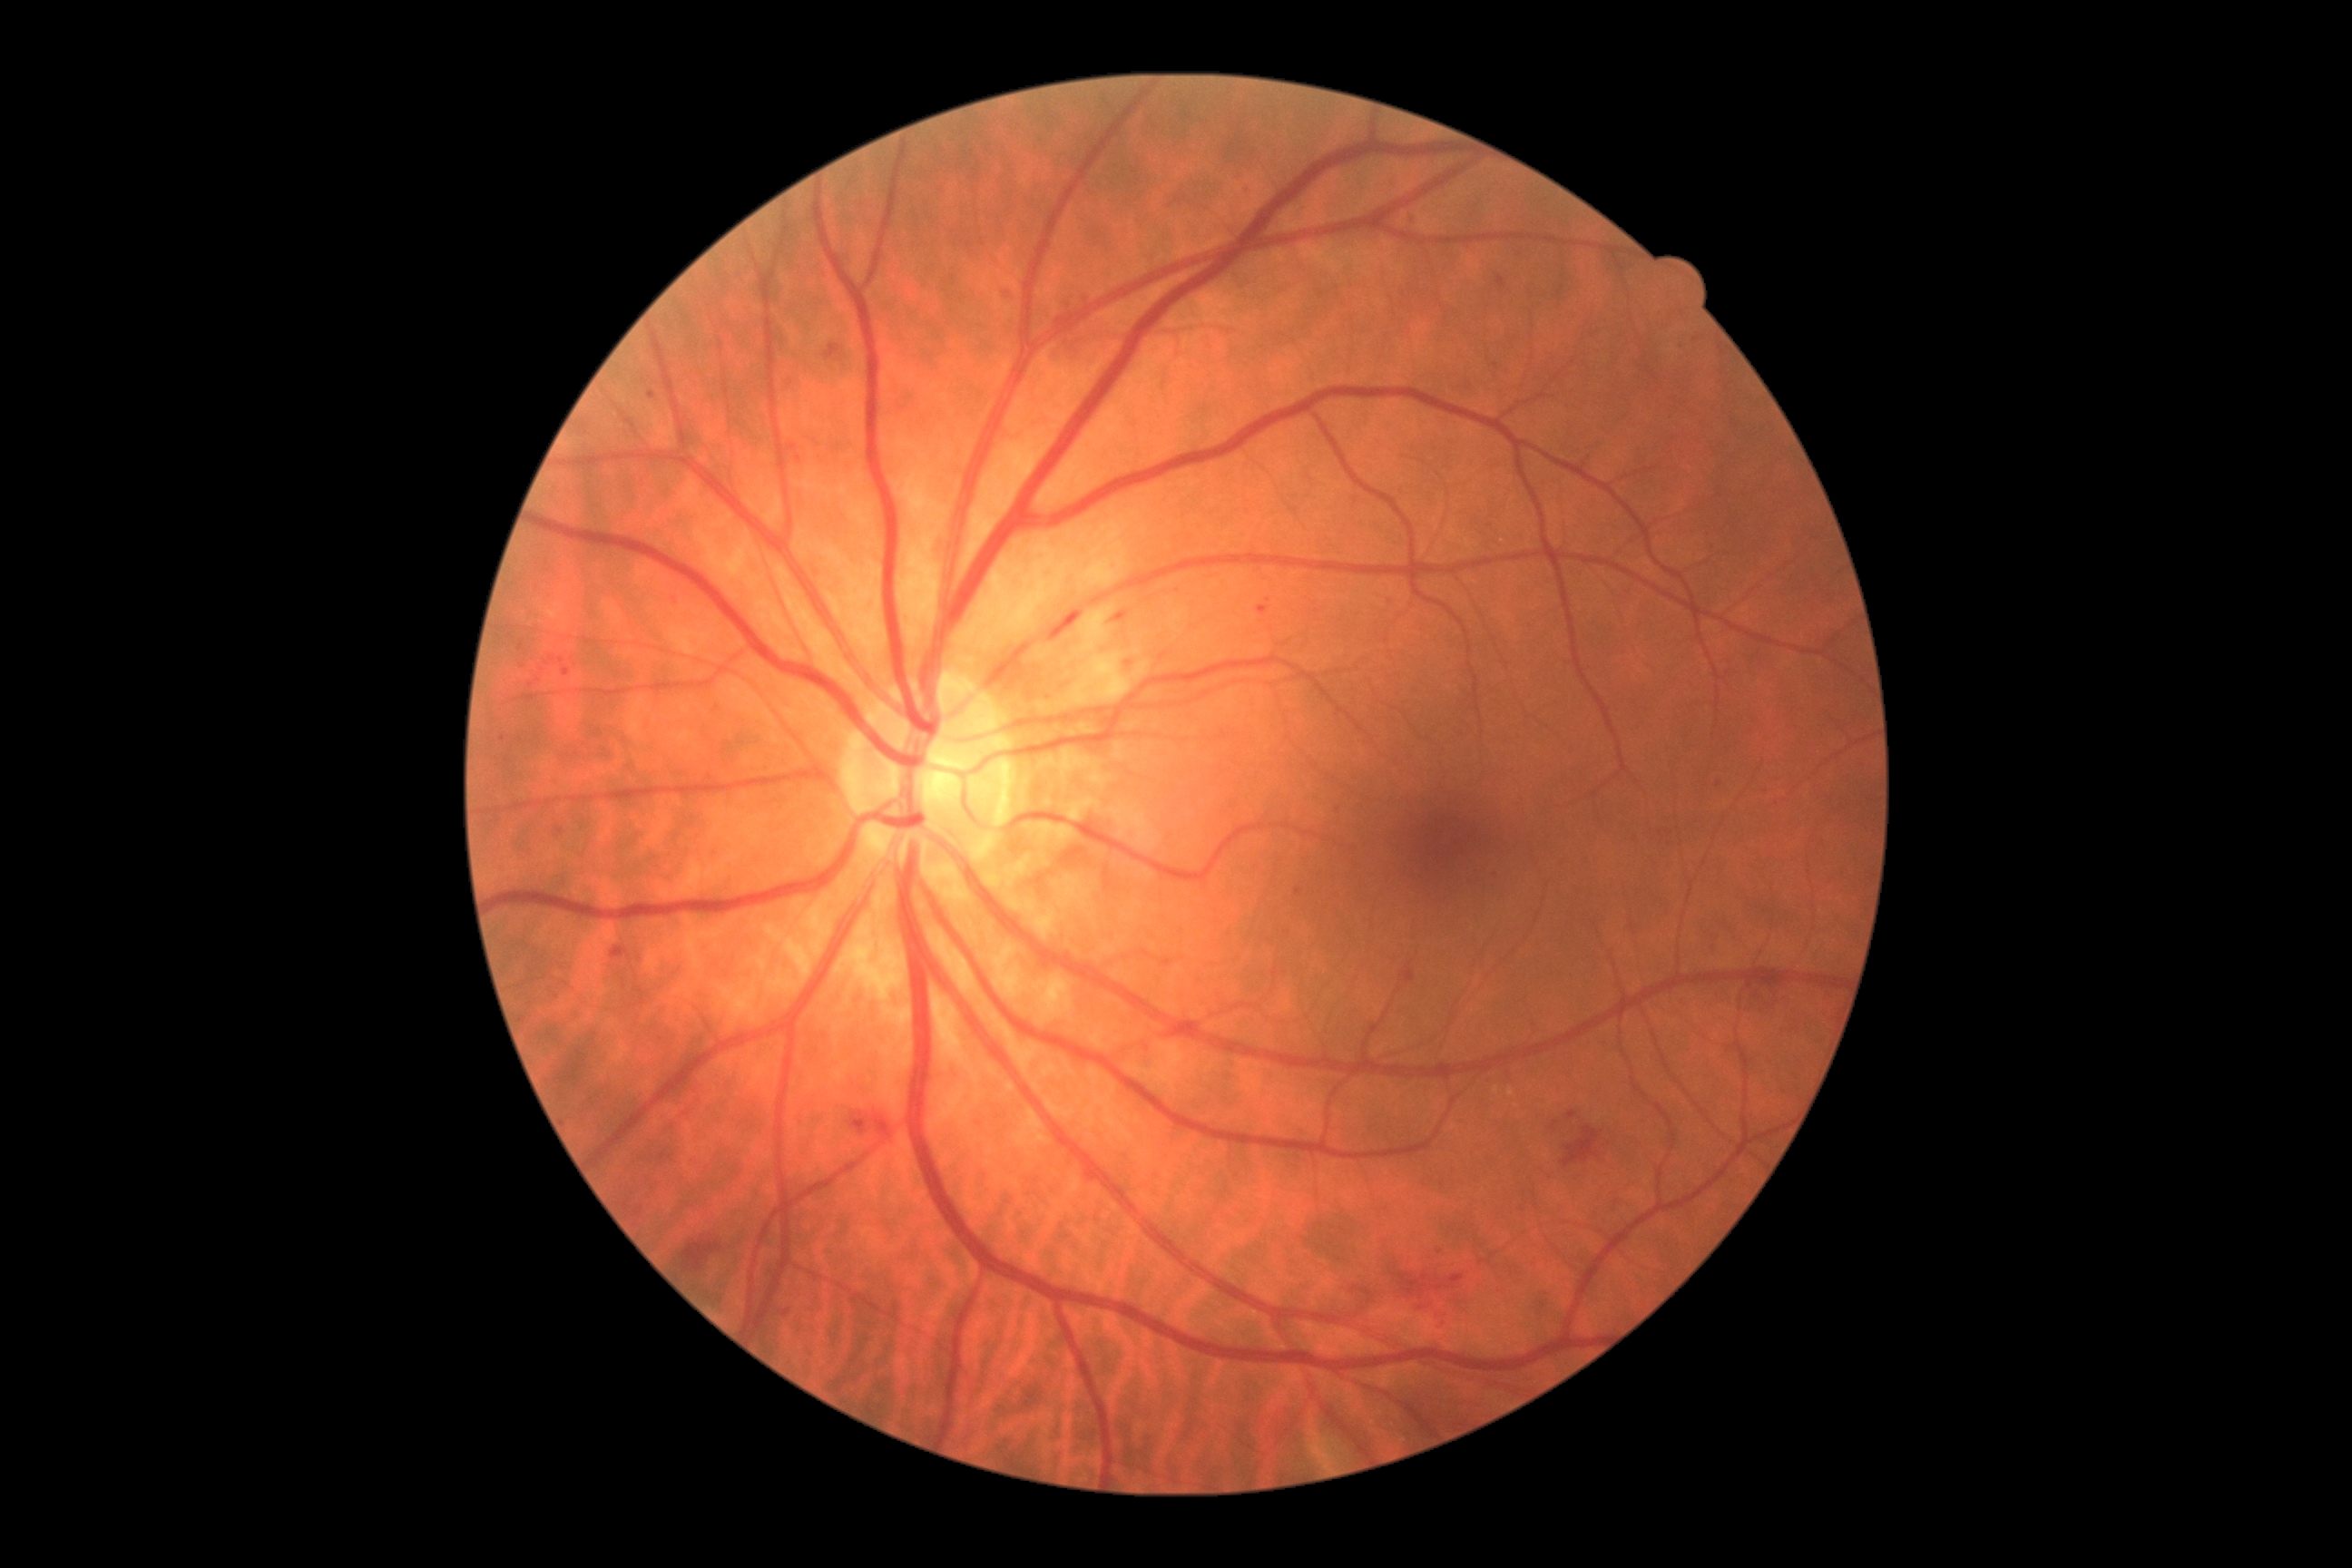
- DR stage: moderate non-proliferative diabetic retinopathy (grade 2)